2048x1536px; 45° field of view; fundus photo.
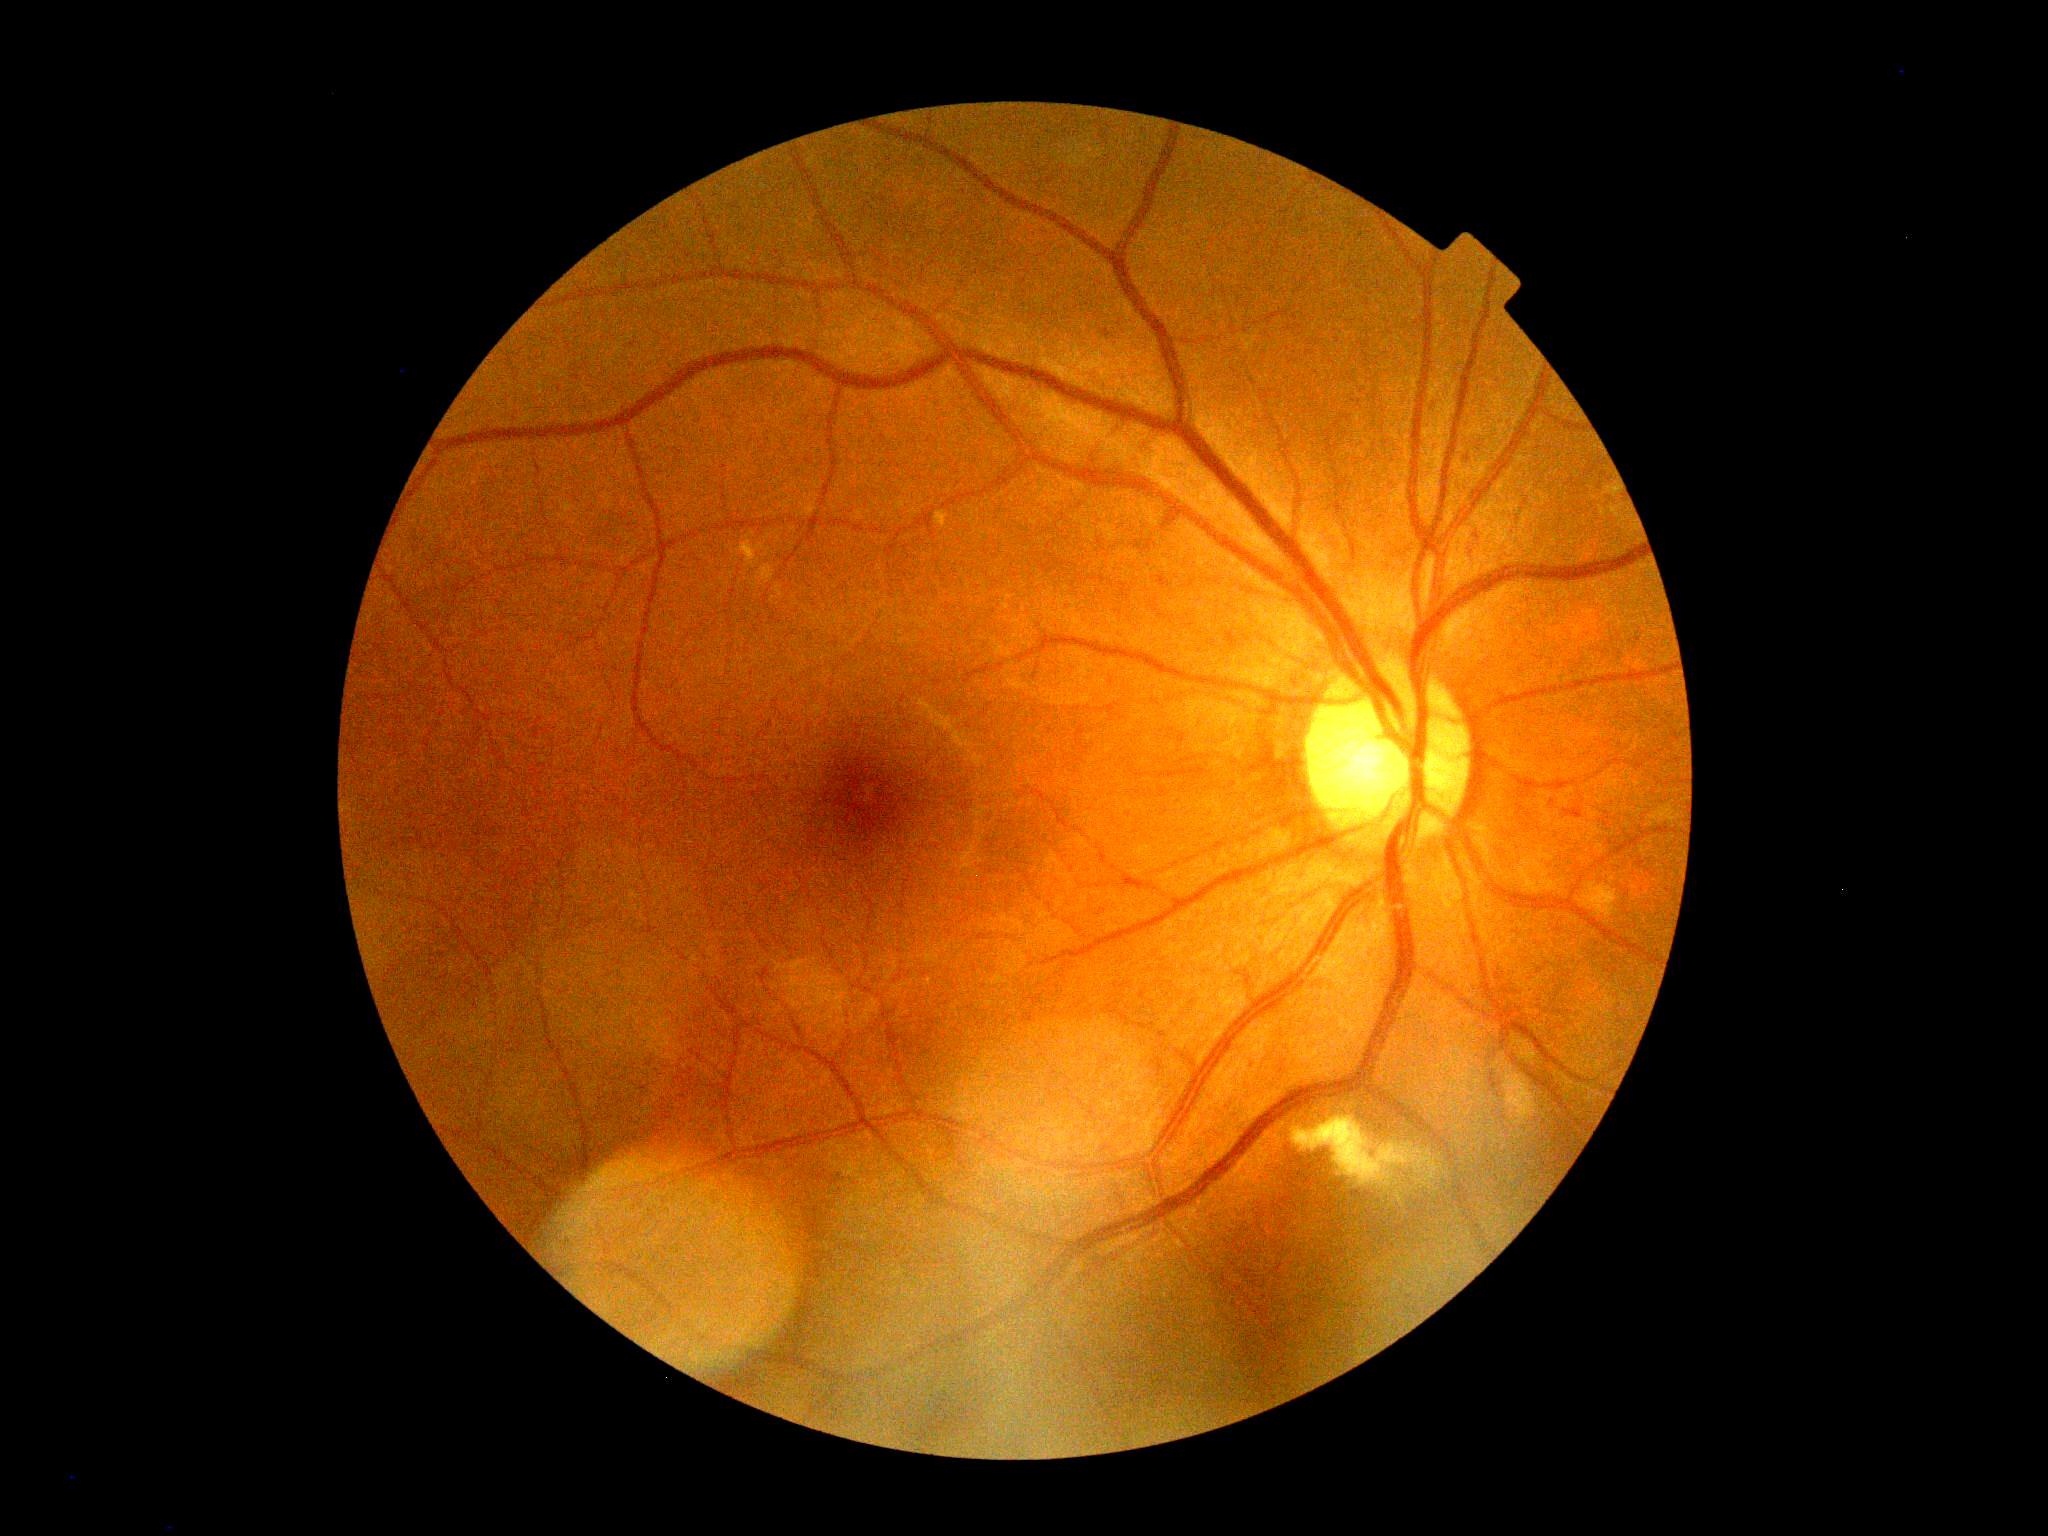
Retinopathy is grade 2.